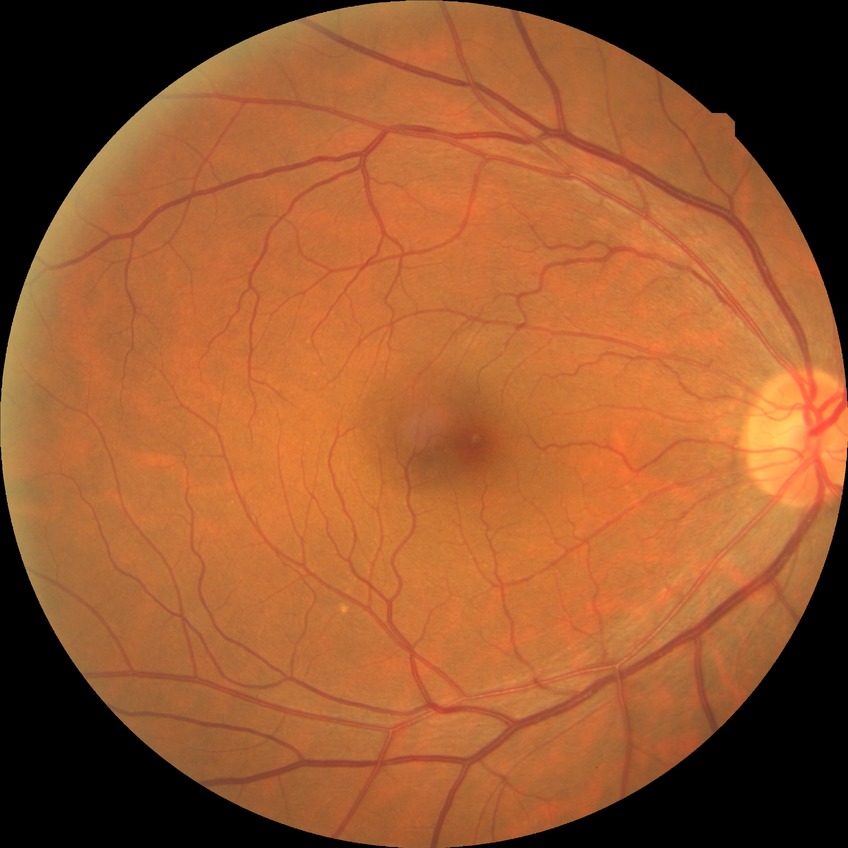
Diabetic retinopathy (DR): no diabetic retinopathy (NDR).